CFP:
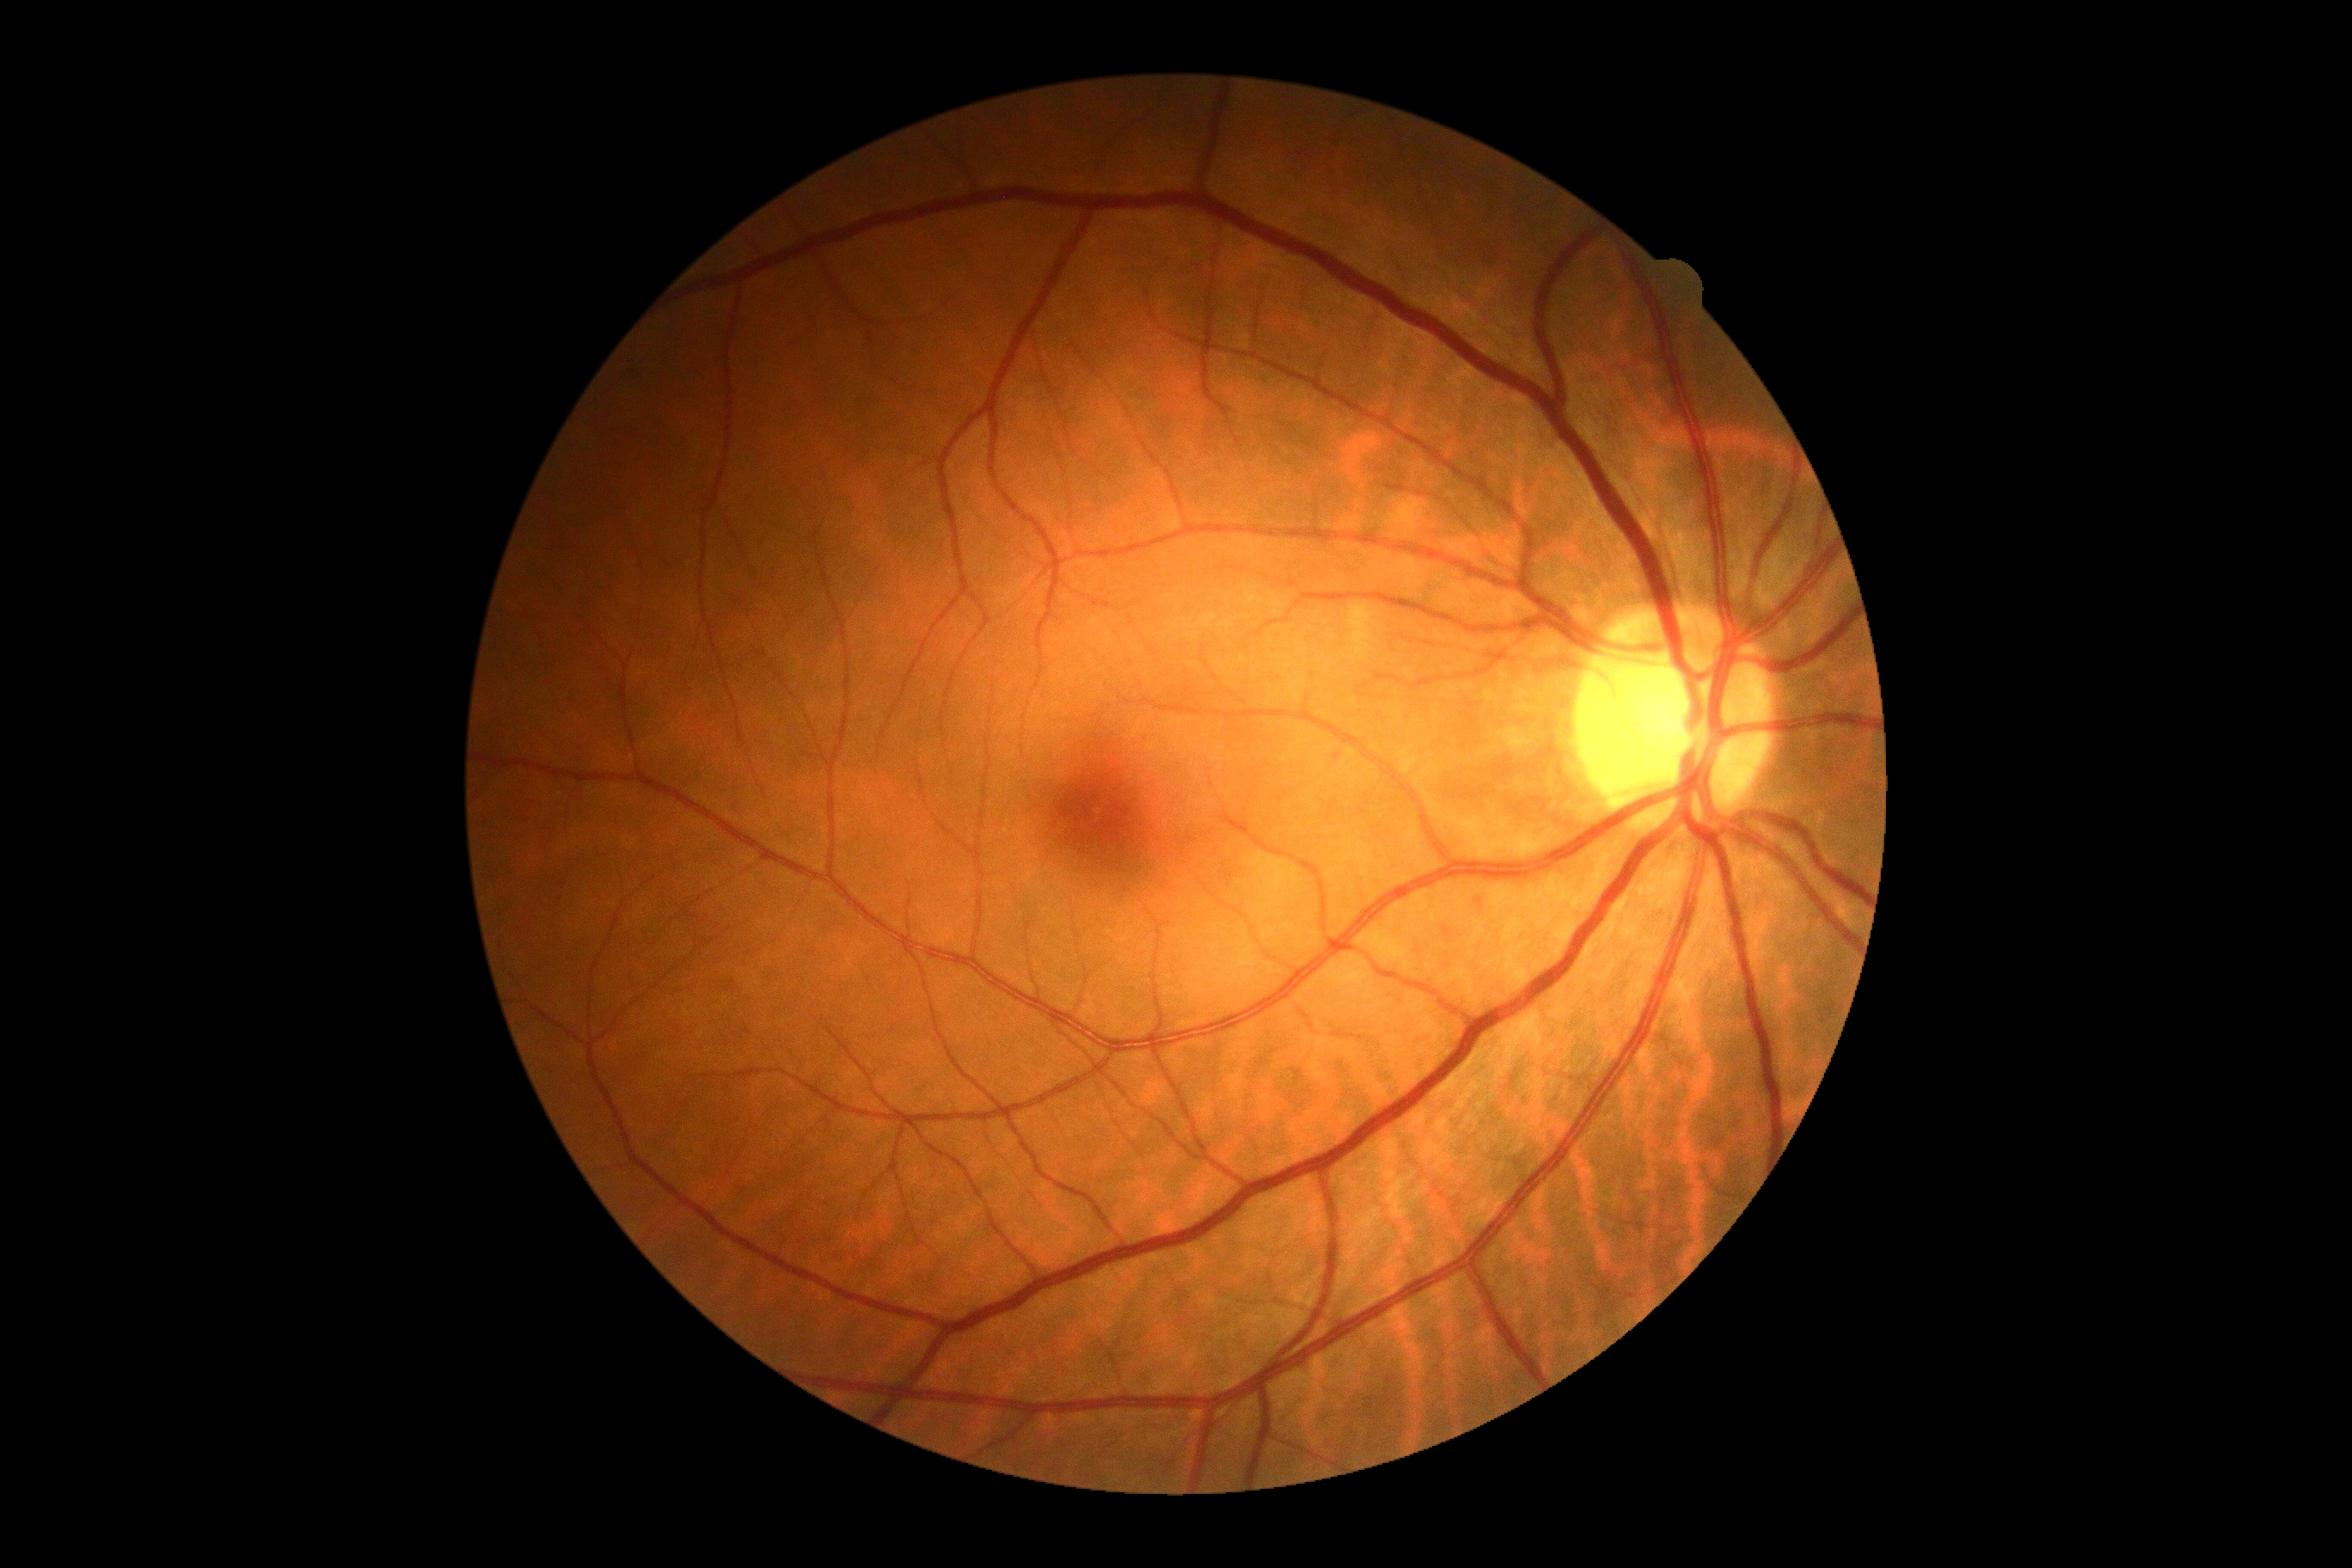
DR=no apparent diabetic retinopathy (grade 0).